45-degree field of view
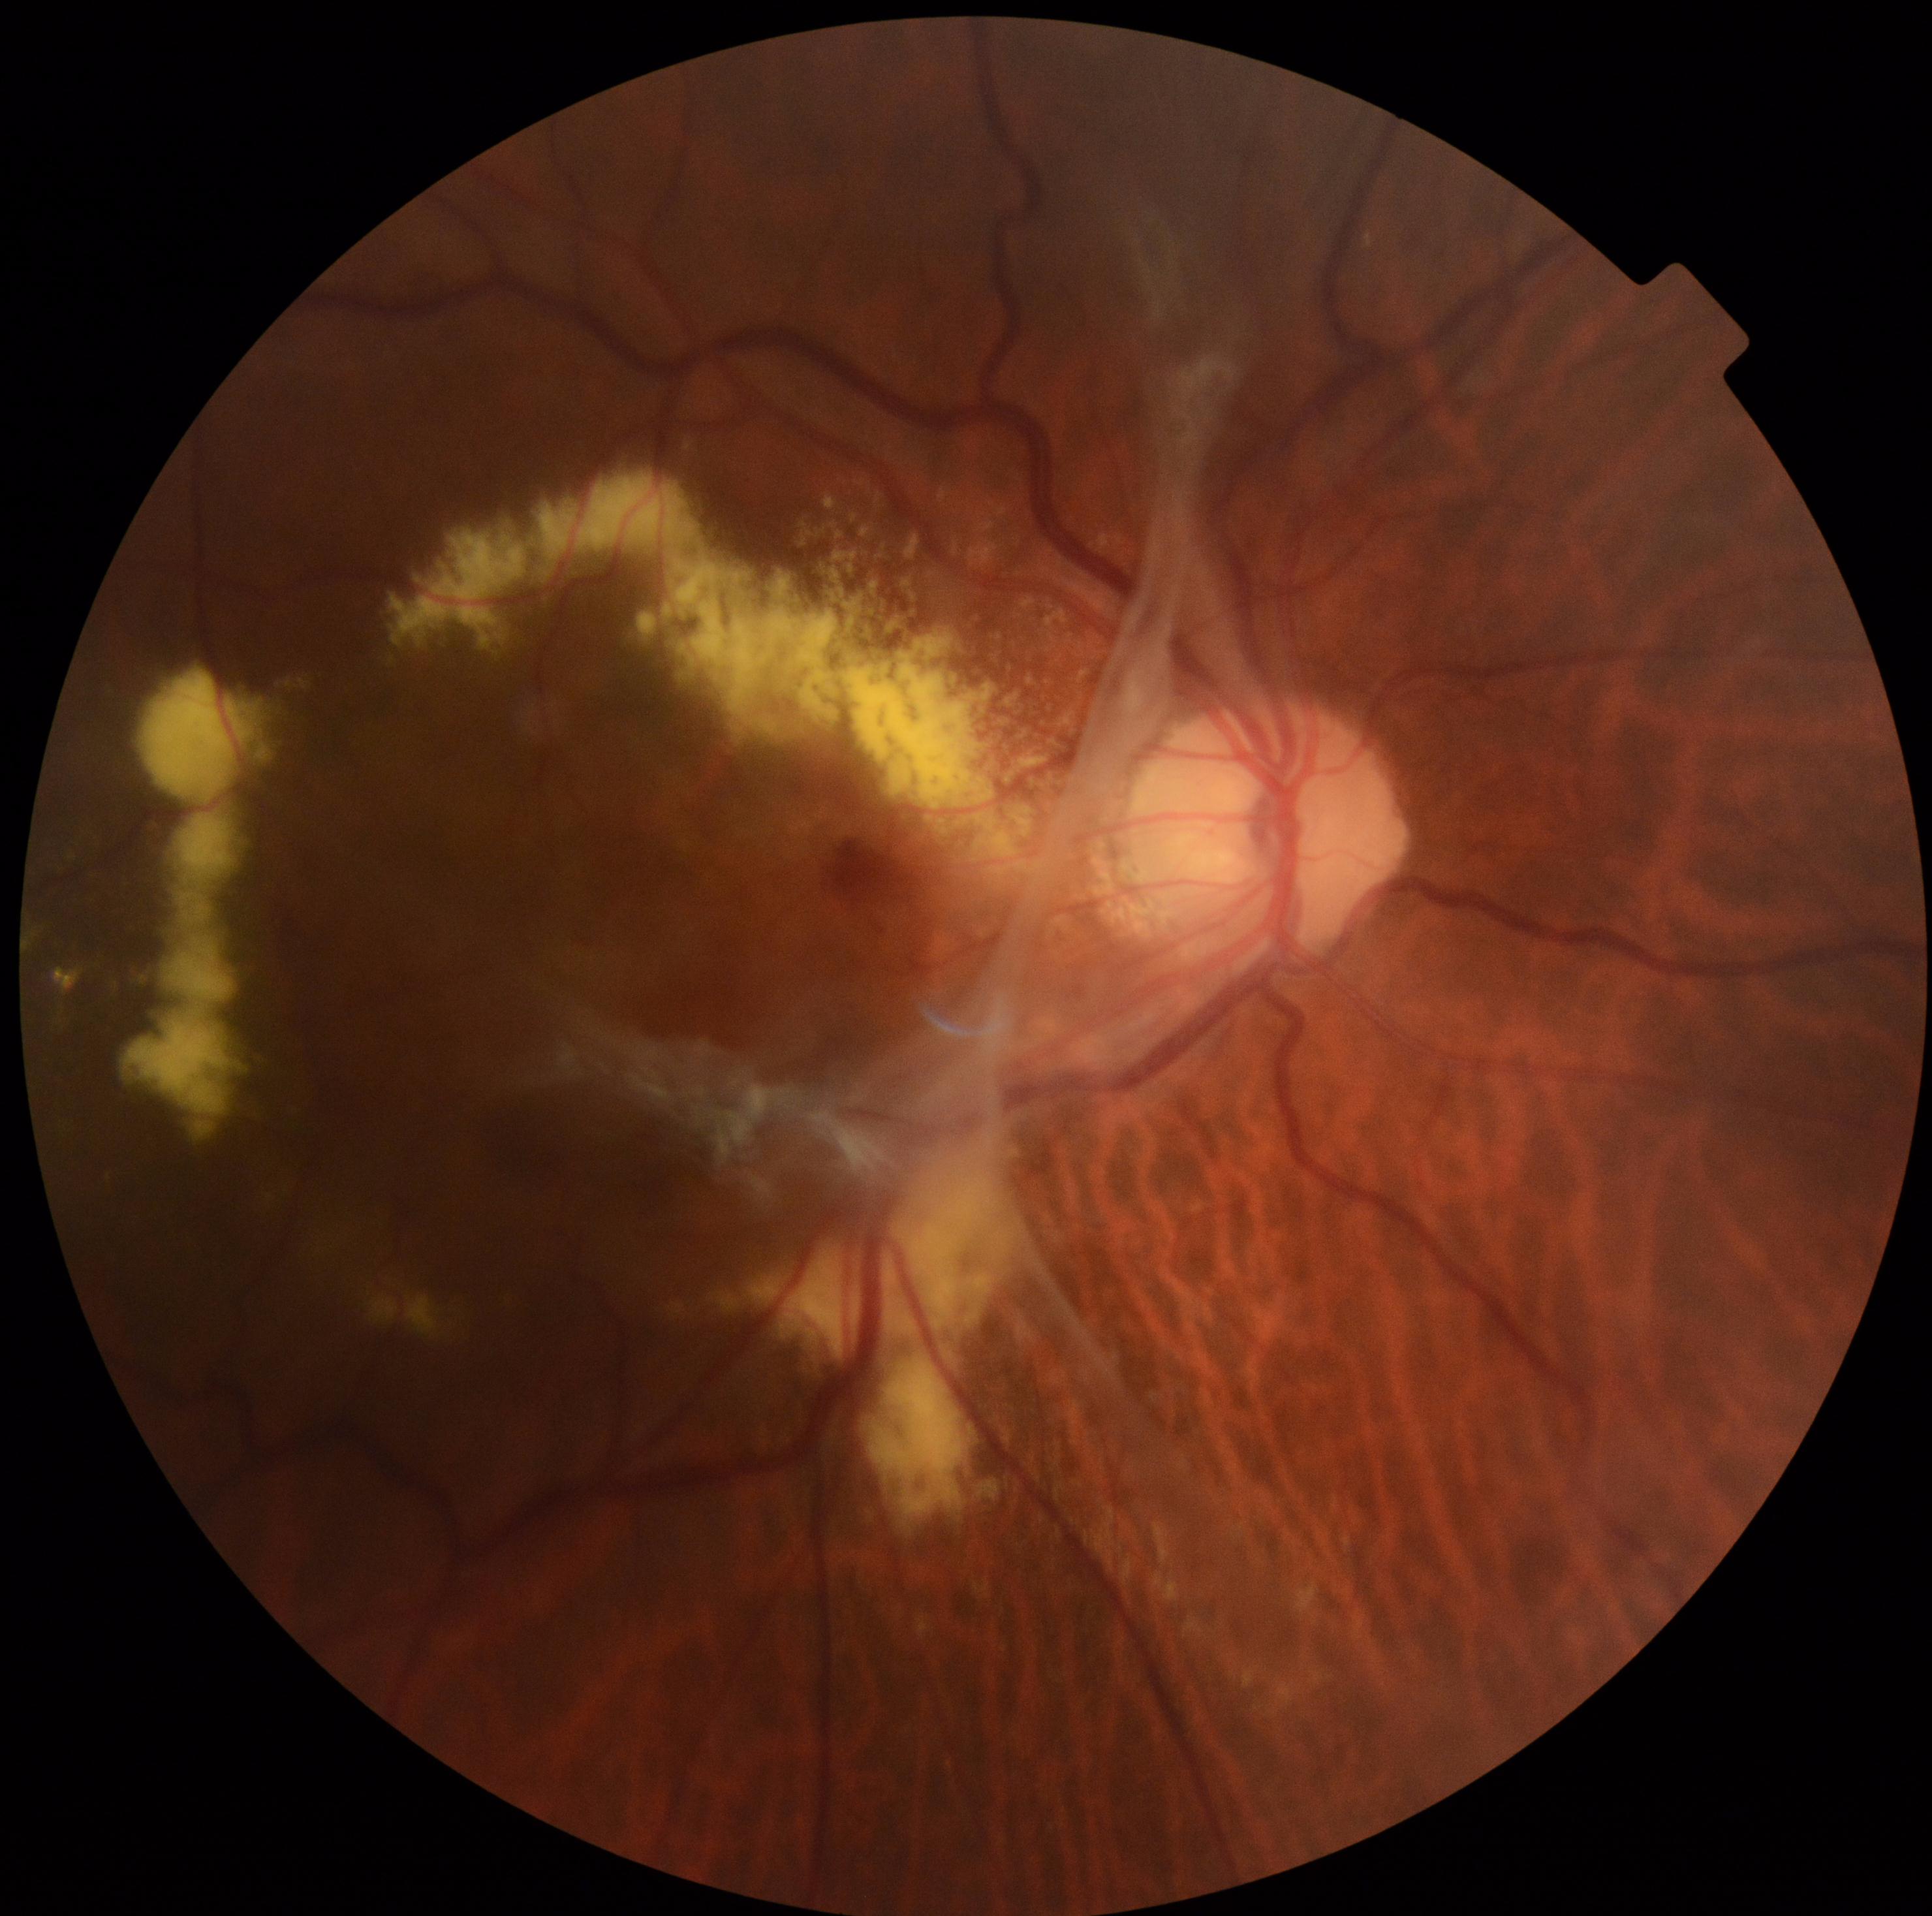

DR: grade 4 (PDR).